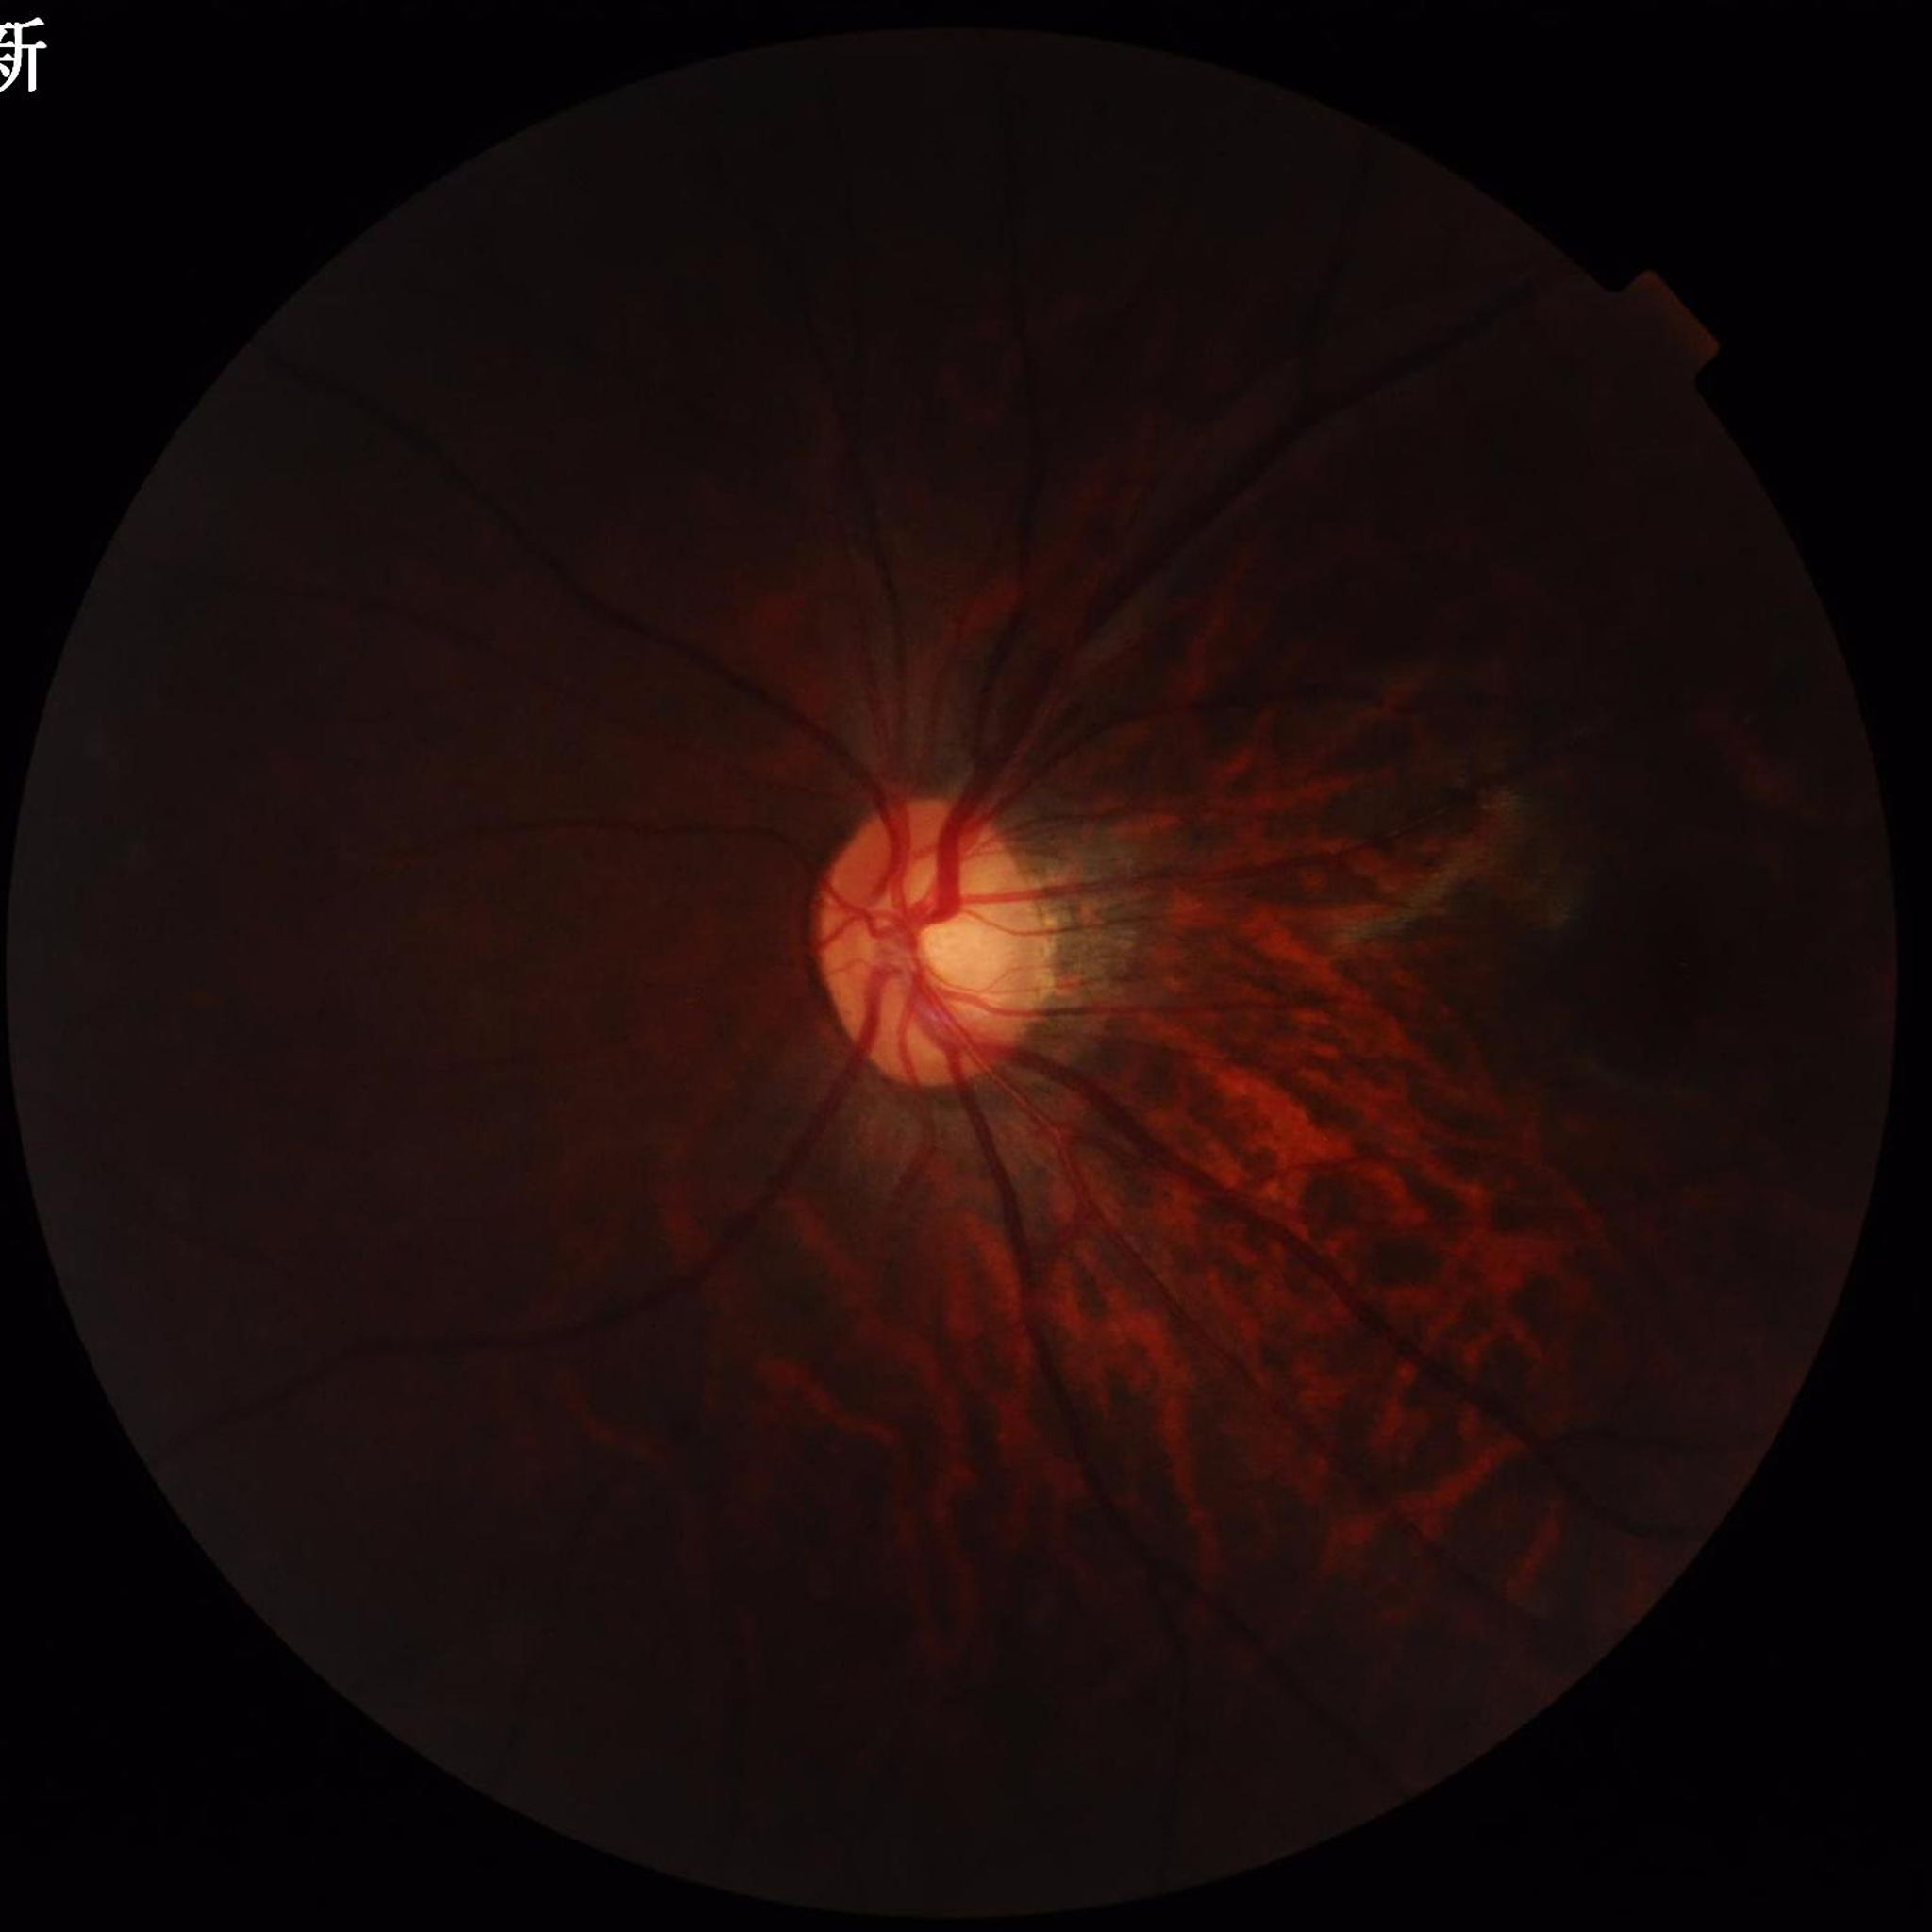
Quality assessment: poor — blur, low contrast, illumination/color distortion. Diagnosed with glaucoma.